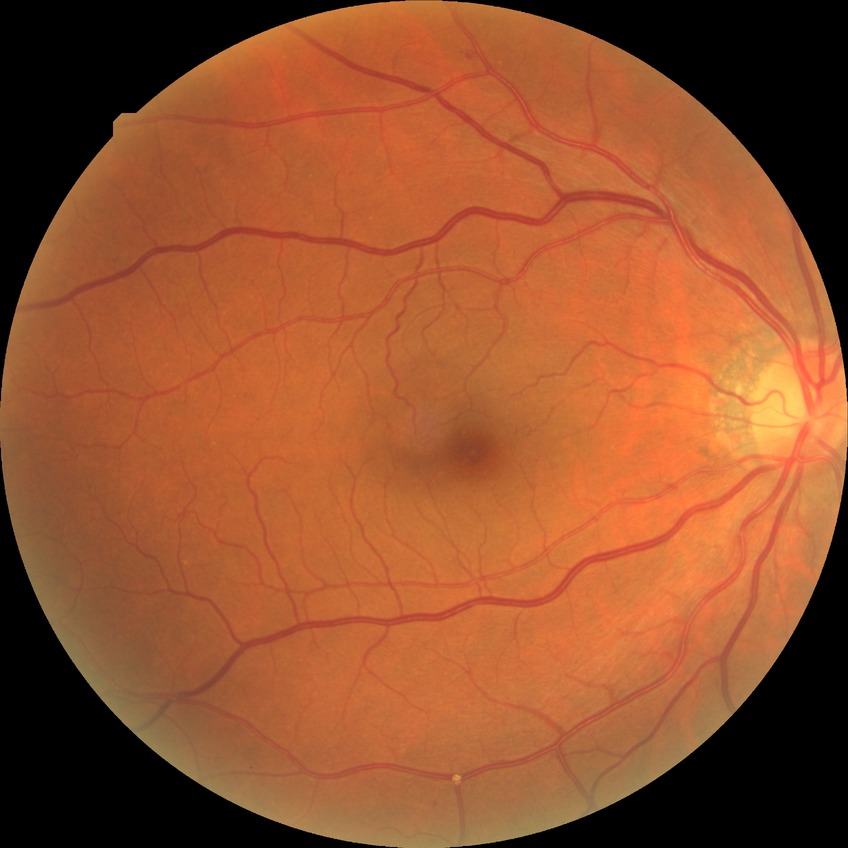 Annotations:
- DR class: non-proliferative diabetic retinopathy
- diabetic retinopathy (DR): SDR (simple diabetic retinopathy)